Infant wide-field retinal image.
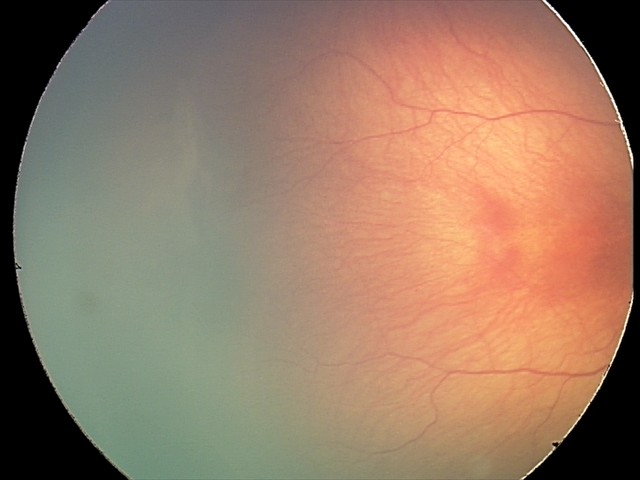

Screening diagnosis: retinopathy of prematurity stage 2 | no plus disease.